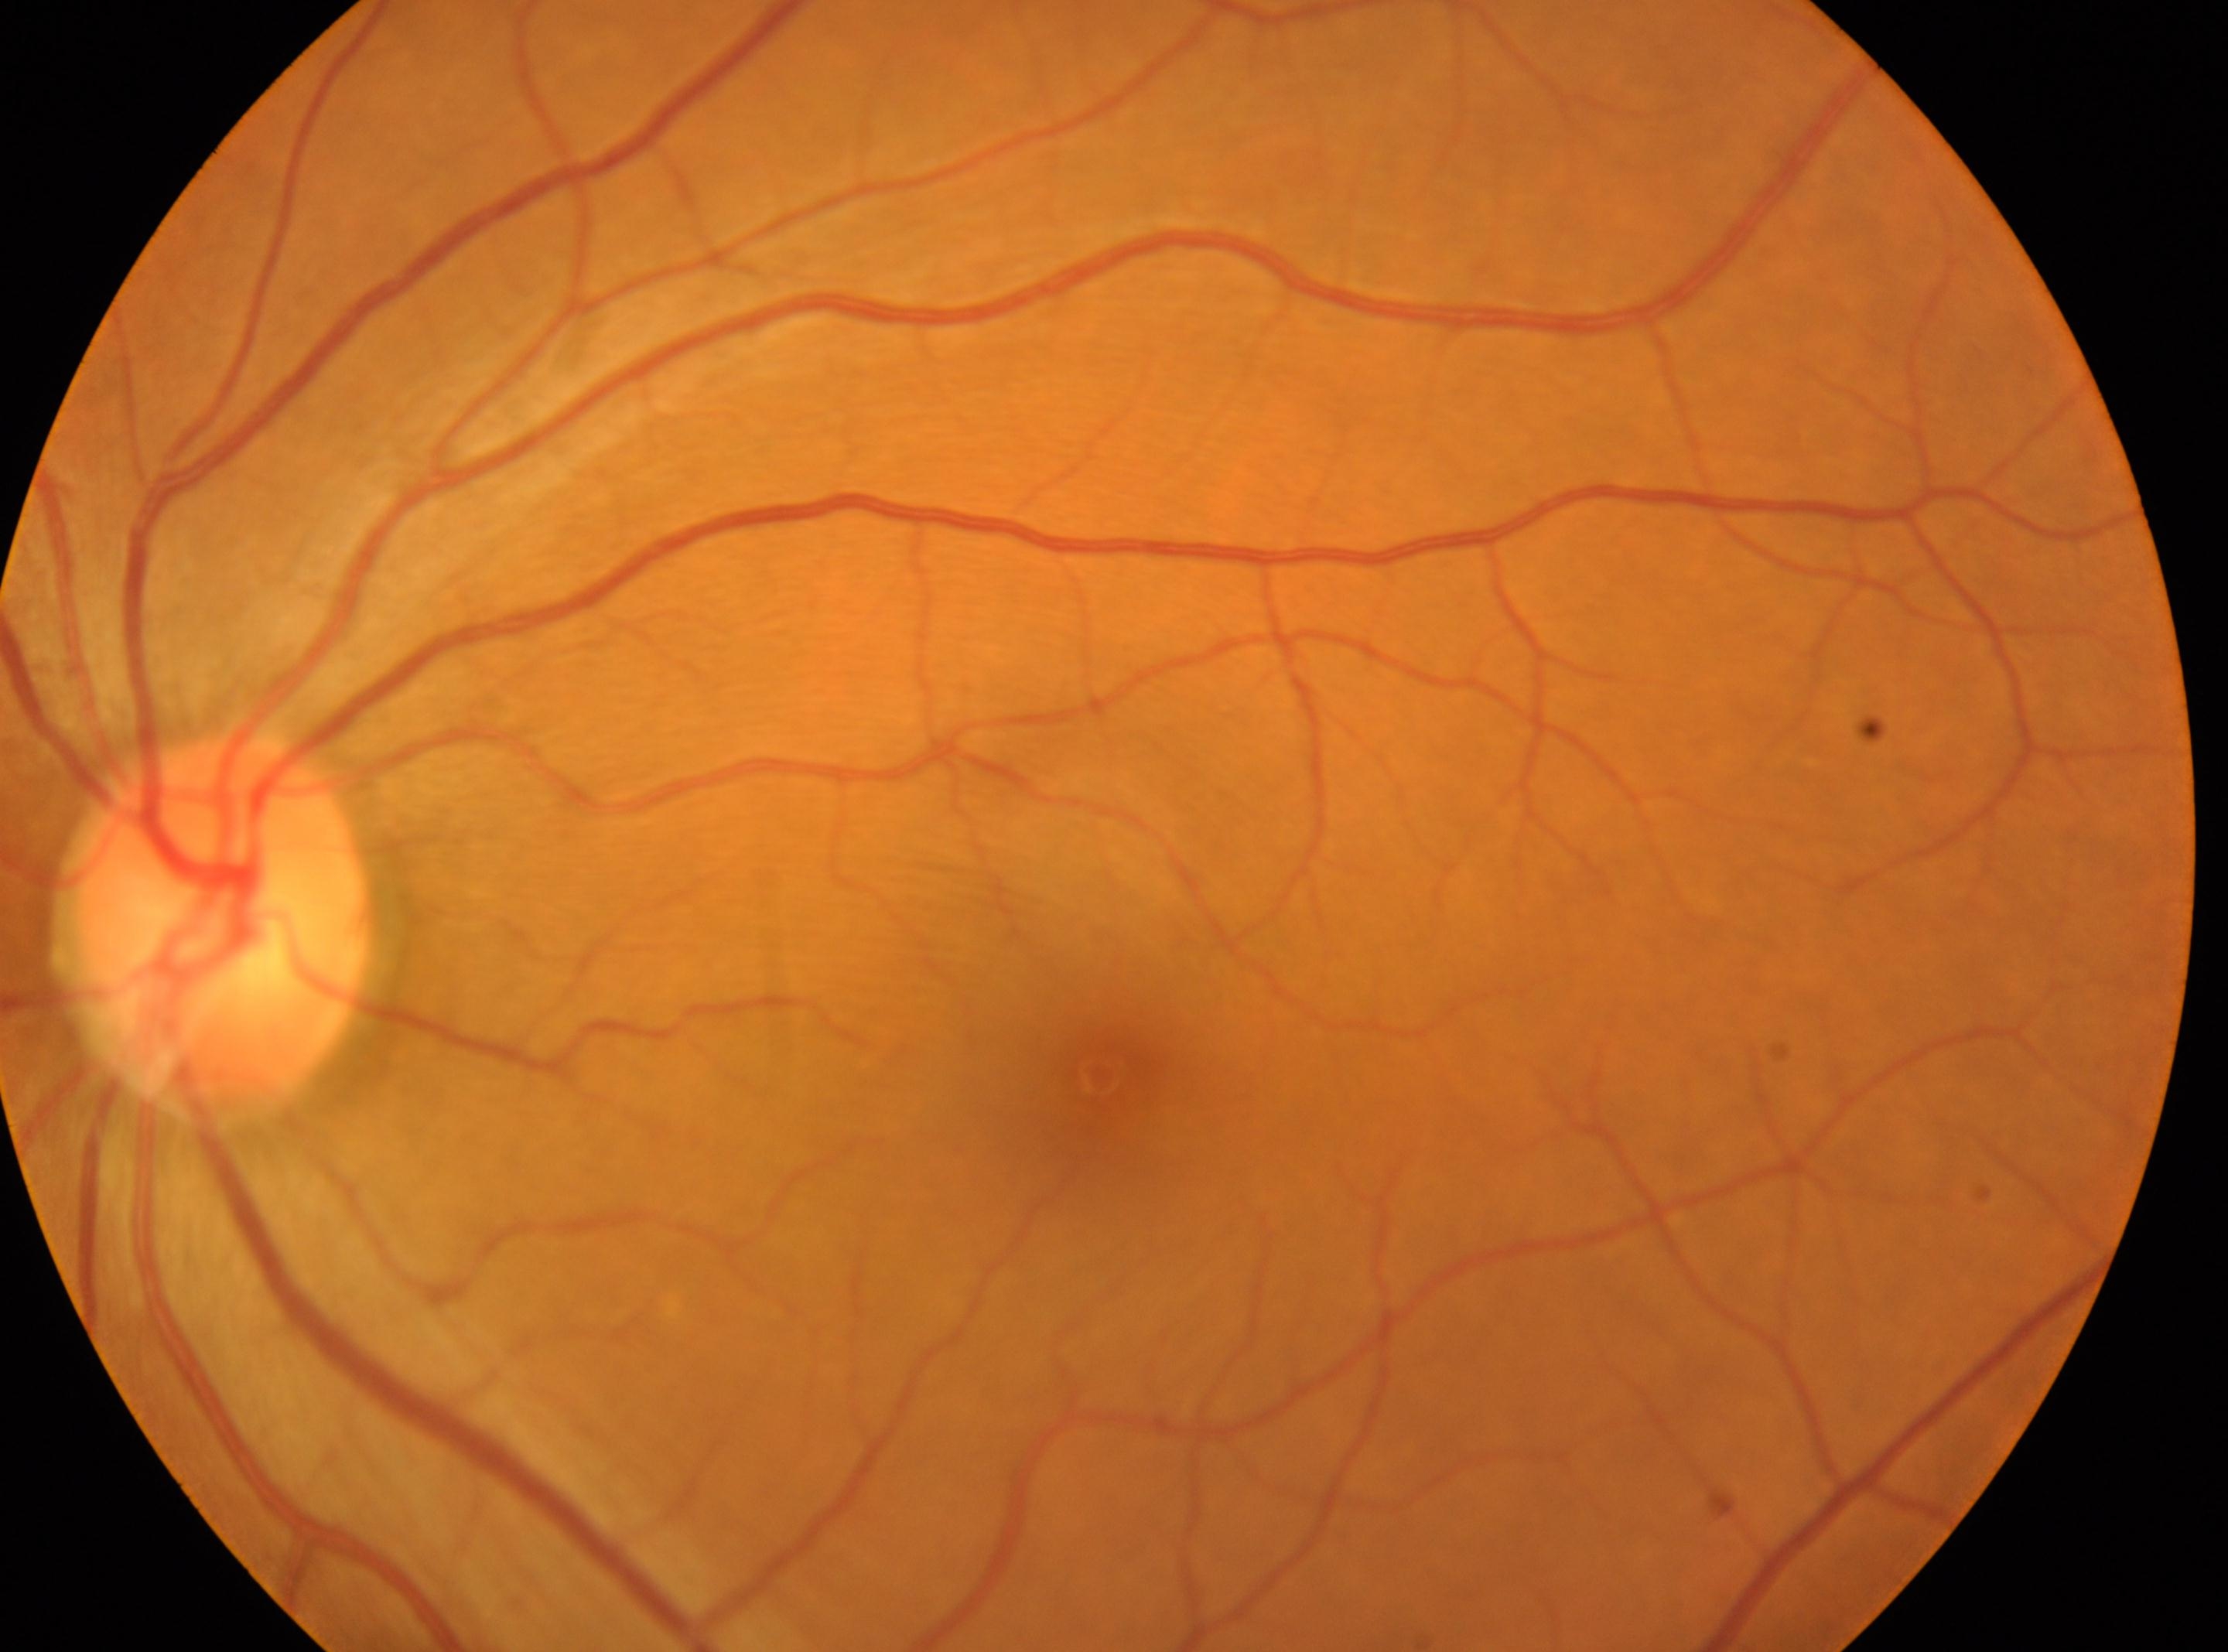 Fovea located at (x=1099, y=1077).
This is the OS.
The optic disc center is at (x=210, y=930).
Diabetic retinopathy severity is no apparent retinopathy (grade 0).